848 by 848 pixels. NIDEK AFC-230. Nonmydriatic. 45 degree fundus photograph. Color fundus photograph: 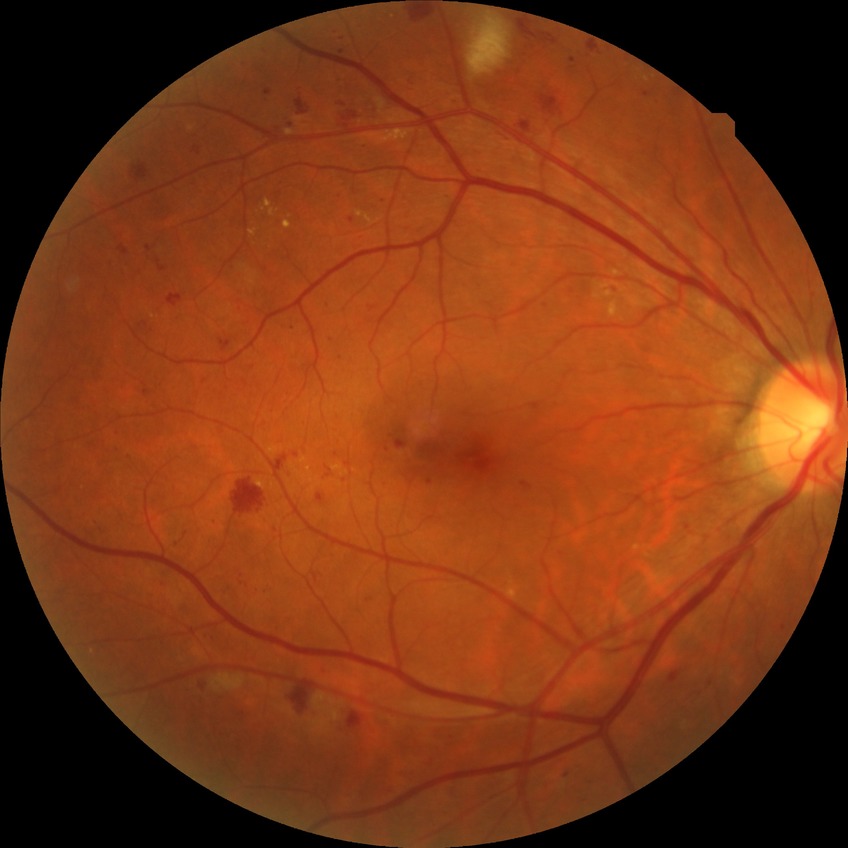
Modified Davis classification: pre-proliferative diabetic retinopathy.